848x848px · nonmydriatic · retinal fundus photograph:
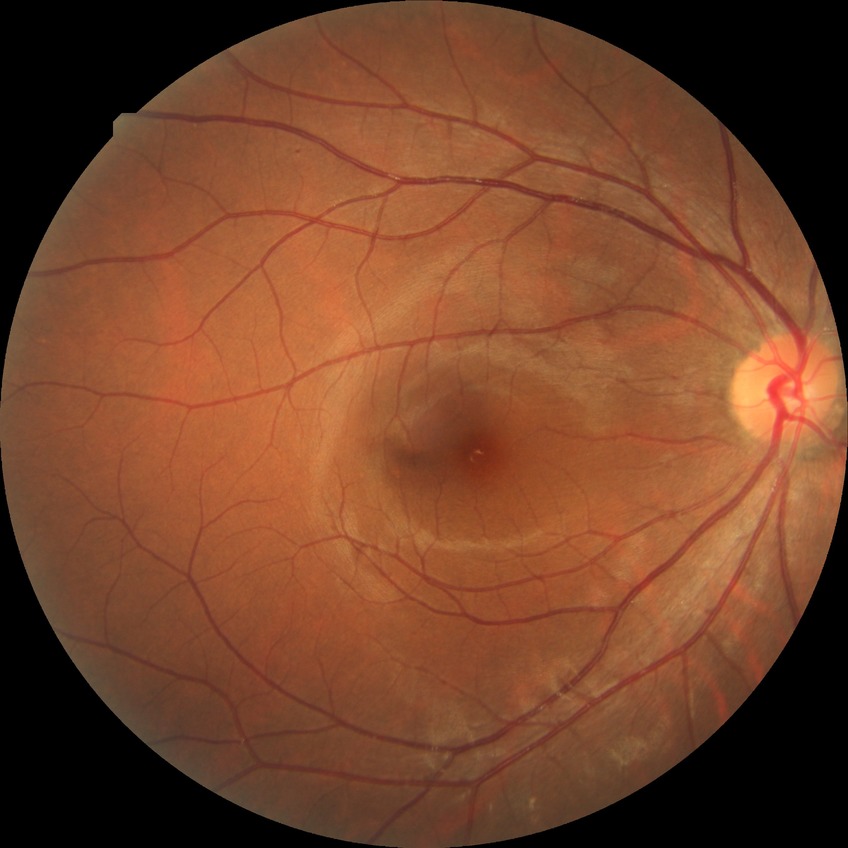

DR severity is NDR.